Nonmydriatic fundus photograph. Diabetic retinopathy graded by the modified Davis classification:
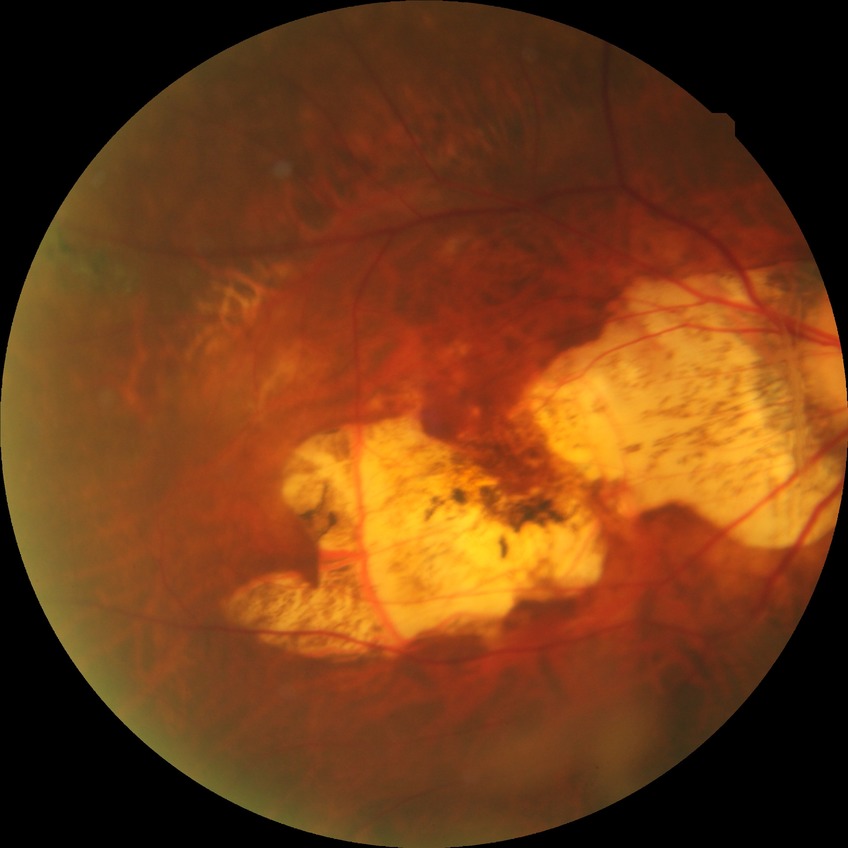
Retinopathy grade is no diabetic retinopathy.